Wide-field fundus image from infant ROP screening — 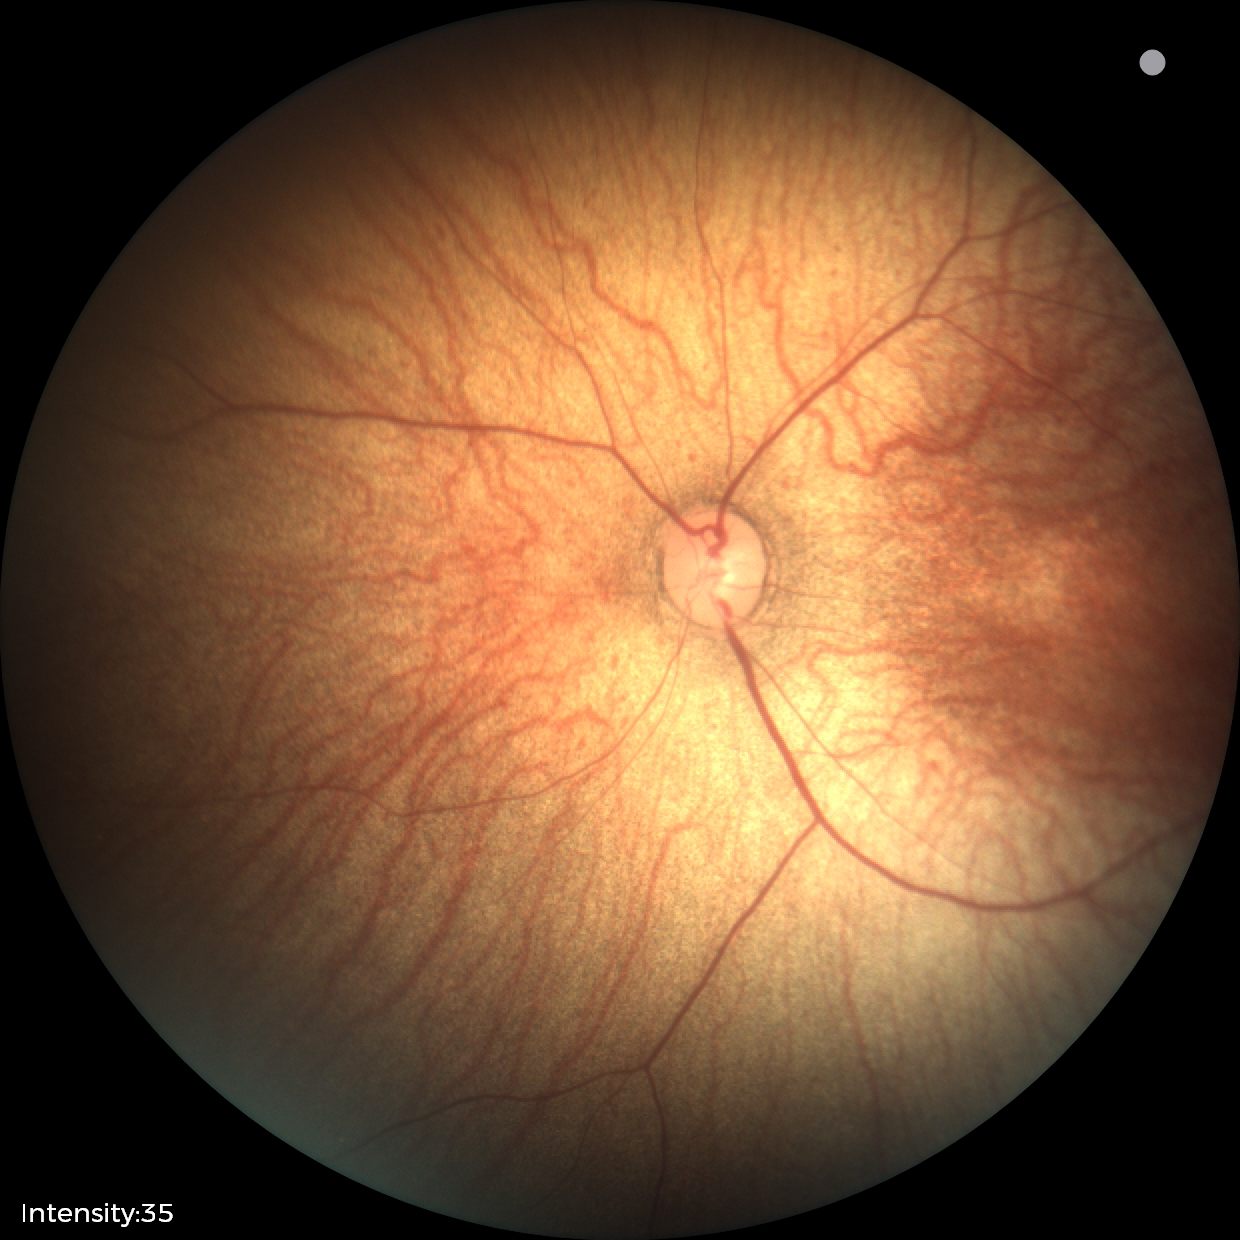
Assessment = no pathology identified.